Fundus photo: 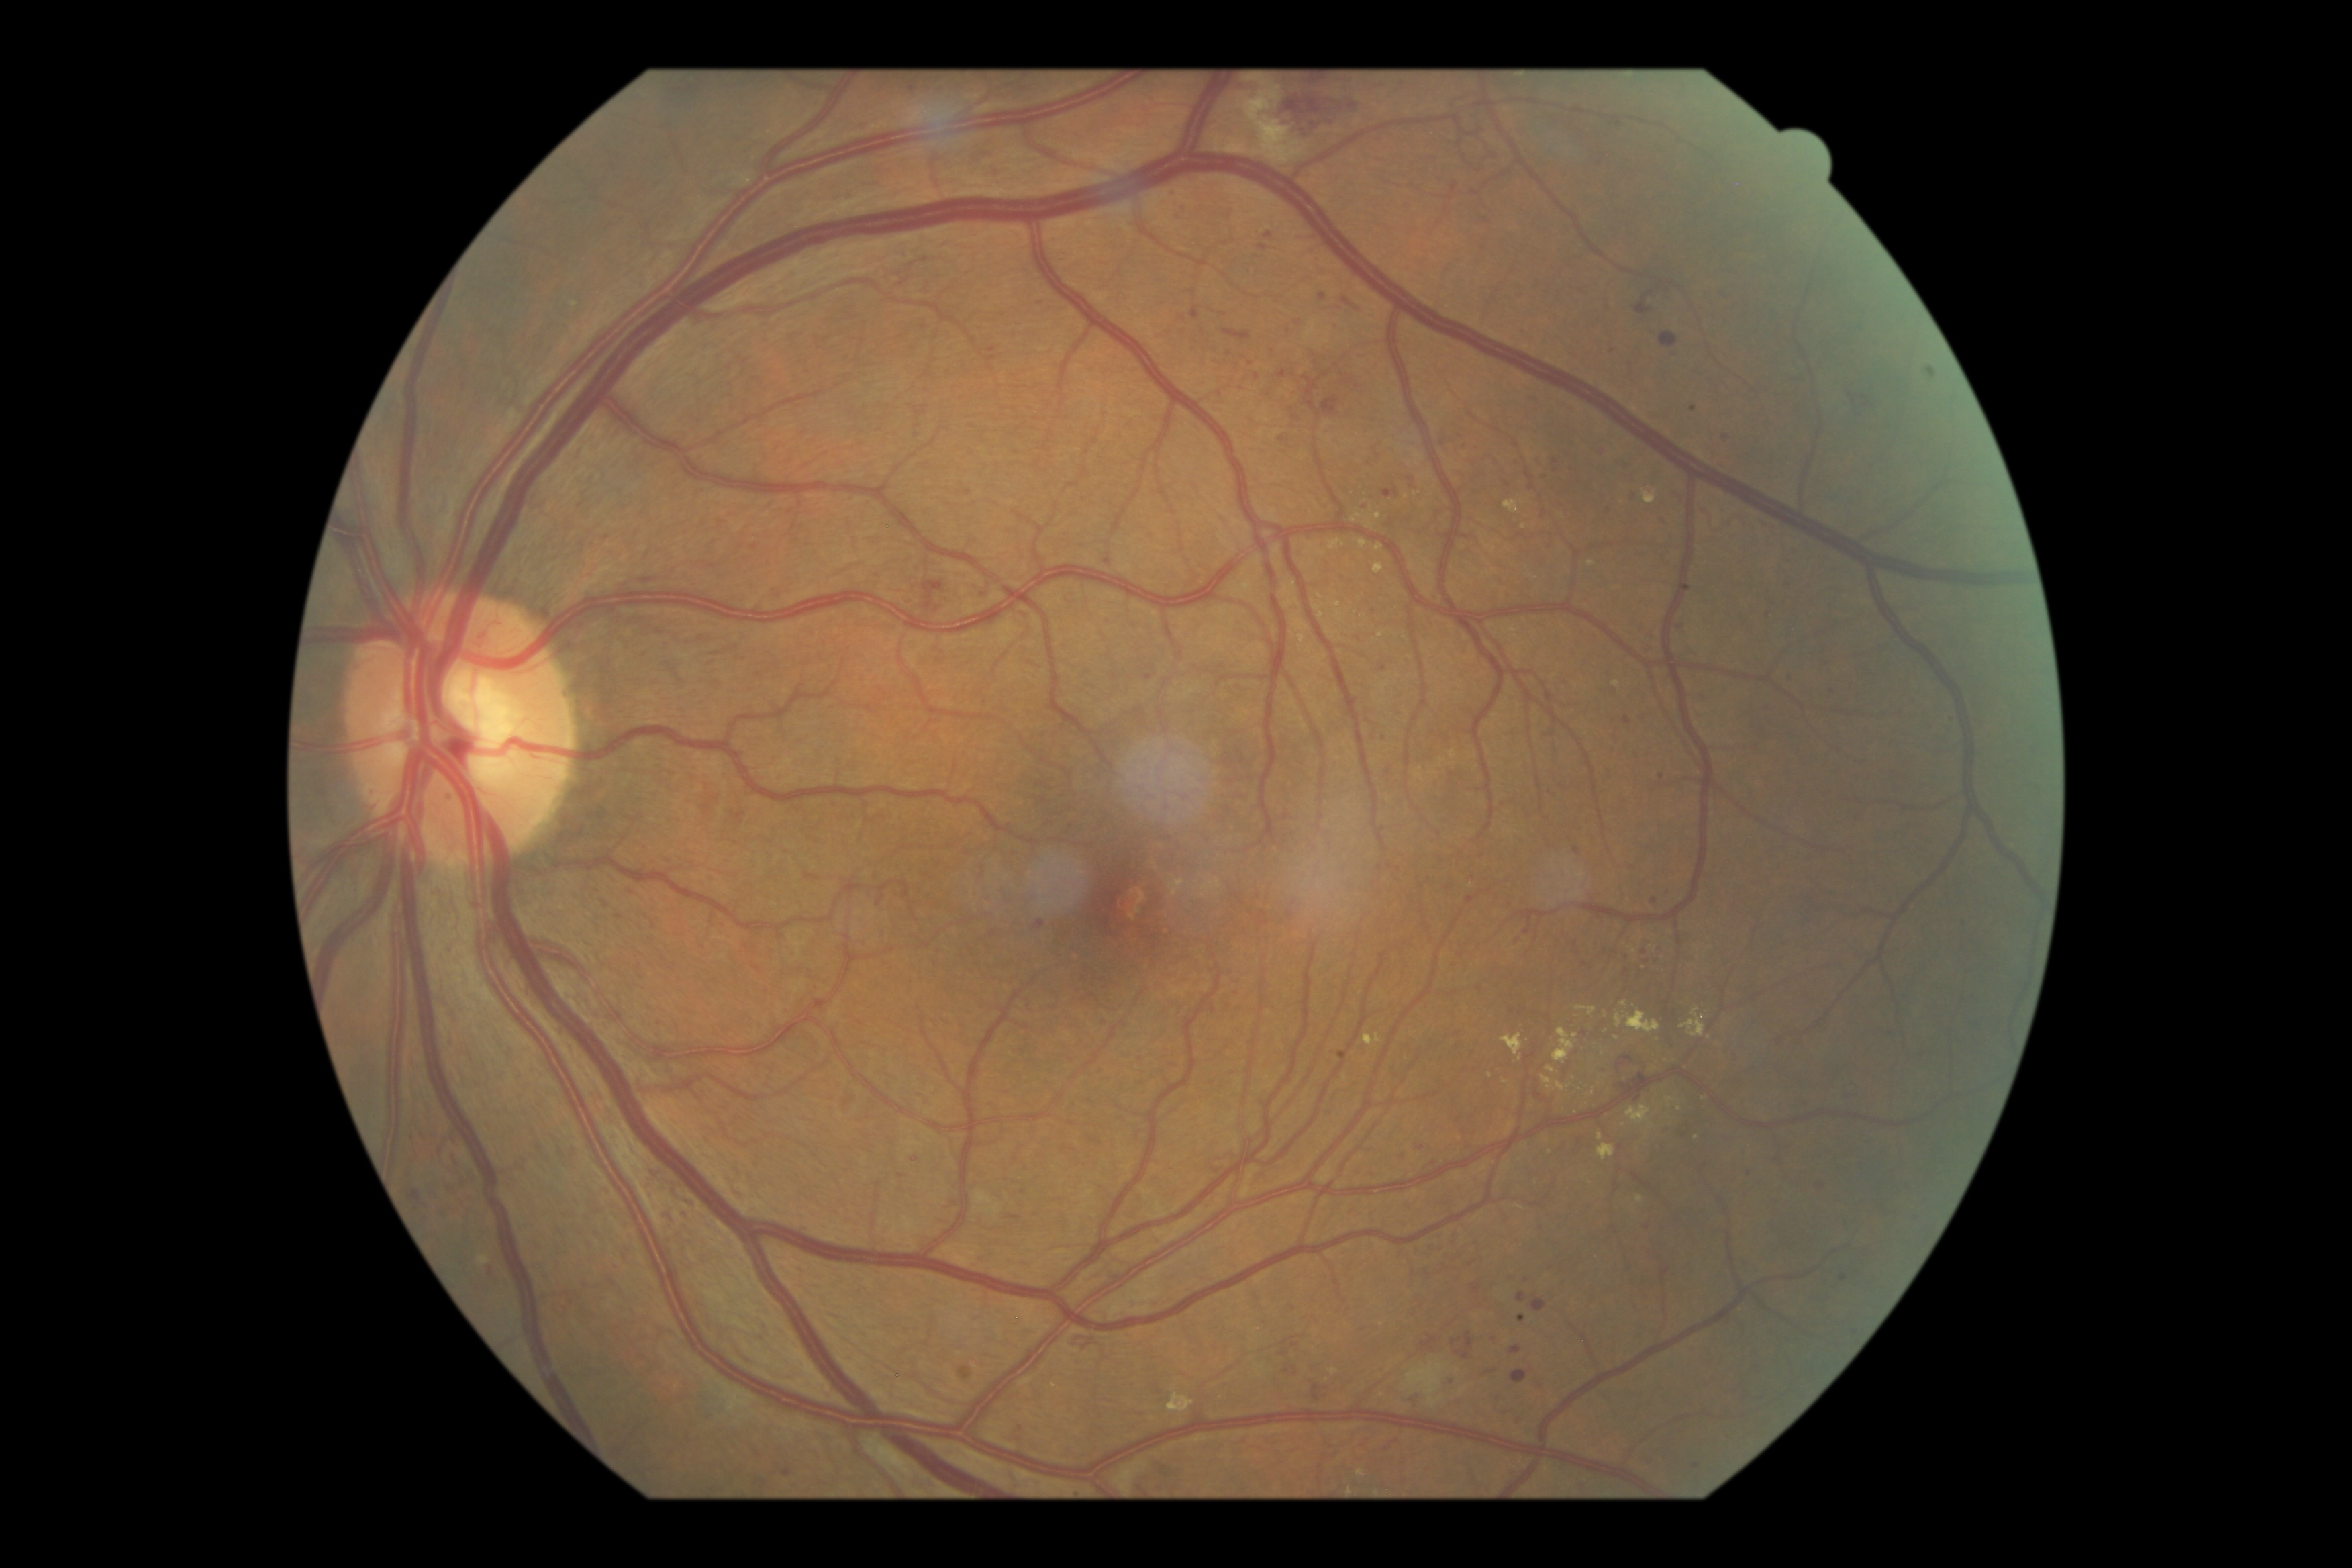
DR severity: grade 3 (severe NPDR)
Lesions identified (partial list):
* MAs (more not shown): bbox=(683, 1210, 688, 1218), bbox=(489, 1265, 495, 1275), bbox=(1515, 939, 1524, 946), bbox=(1036, 920, 1045, 930), bbox=(1528, 398, 1536, 403), bbox=(1320, 293, 1327, 301), bbox=(1357, 505, 1369, 511)
* Small MAs approximately at {"x": 1282, "y": 440}, {"x": 1384, "y": 669}, {"x": 1694, "y": 408}, {"x": 1399, "y": 870}, {"x": 1025, "y": 1192}, {"x": 1572, "y": 466}, {"x": 1346, "y": 301}, {"x": 1108, "y": 562}, {"x": 660, "y": 1023}, {"x": 1822, "y": 1187}, {"x": 1650, "y": 1459}